Image size 848x848. 45 degree fundus photograph. Nonmydriatic fundus photograph
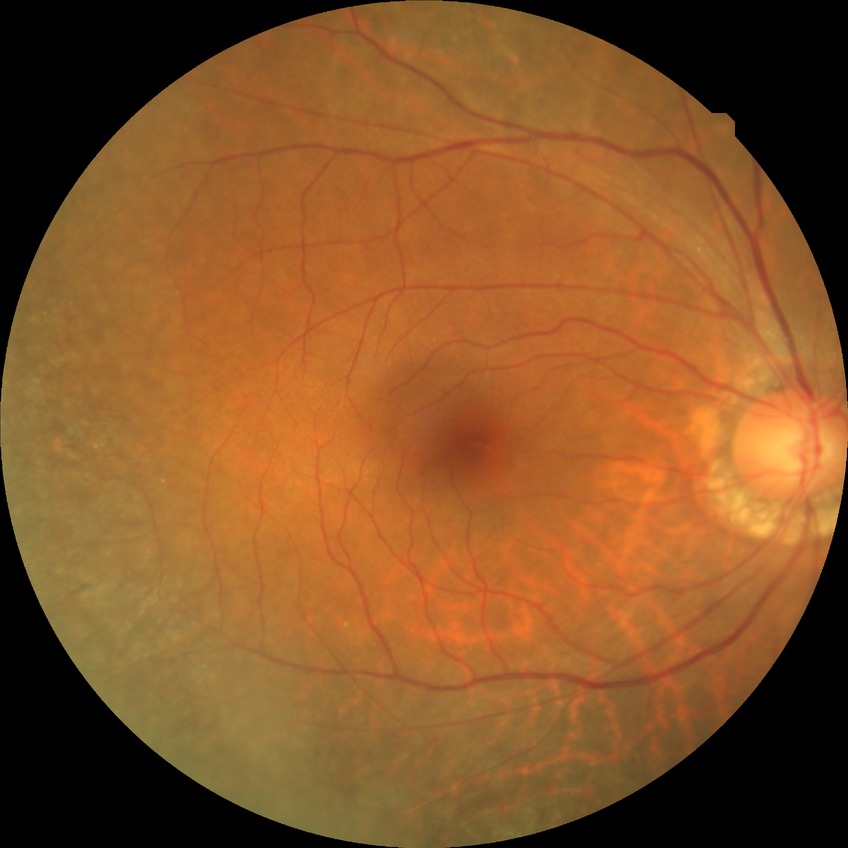

Diabetic retinopathy (DR) is NDR (no diabetic retinopathy).